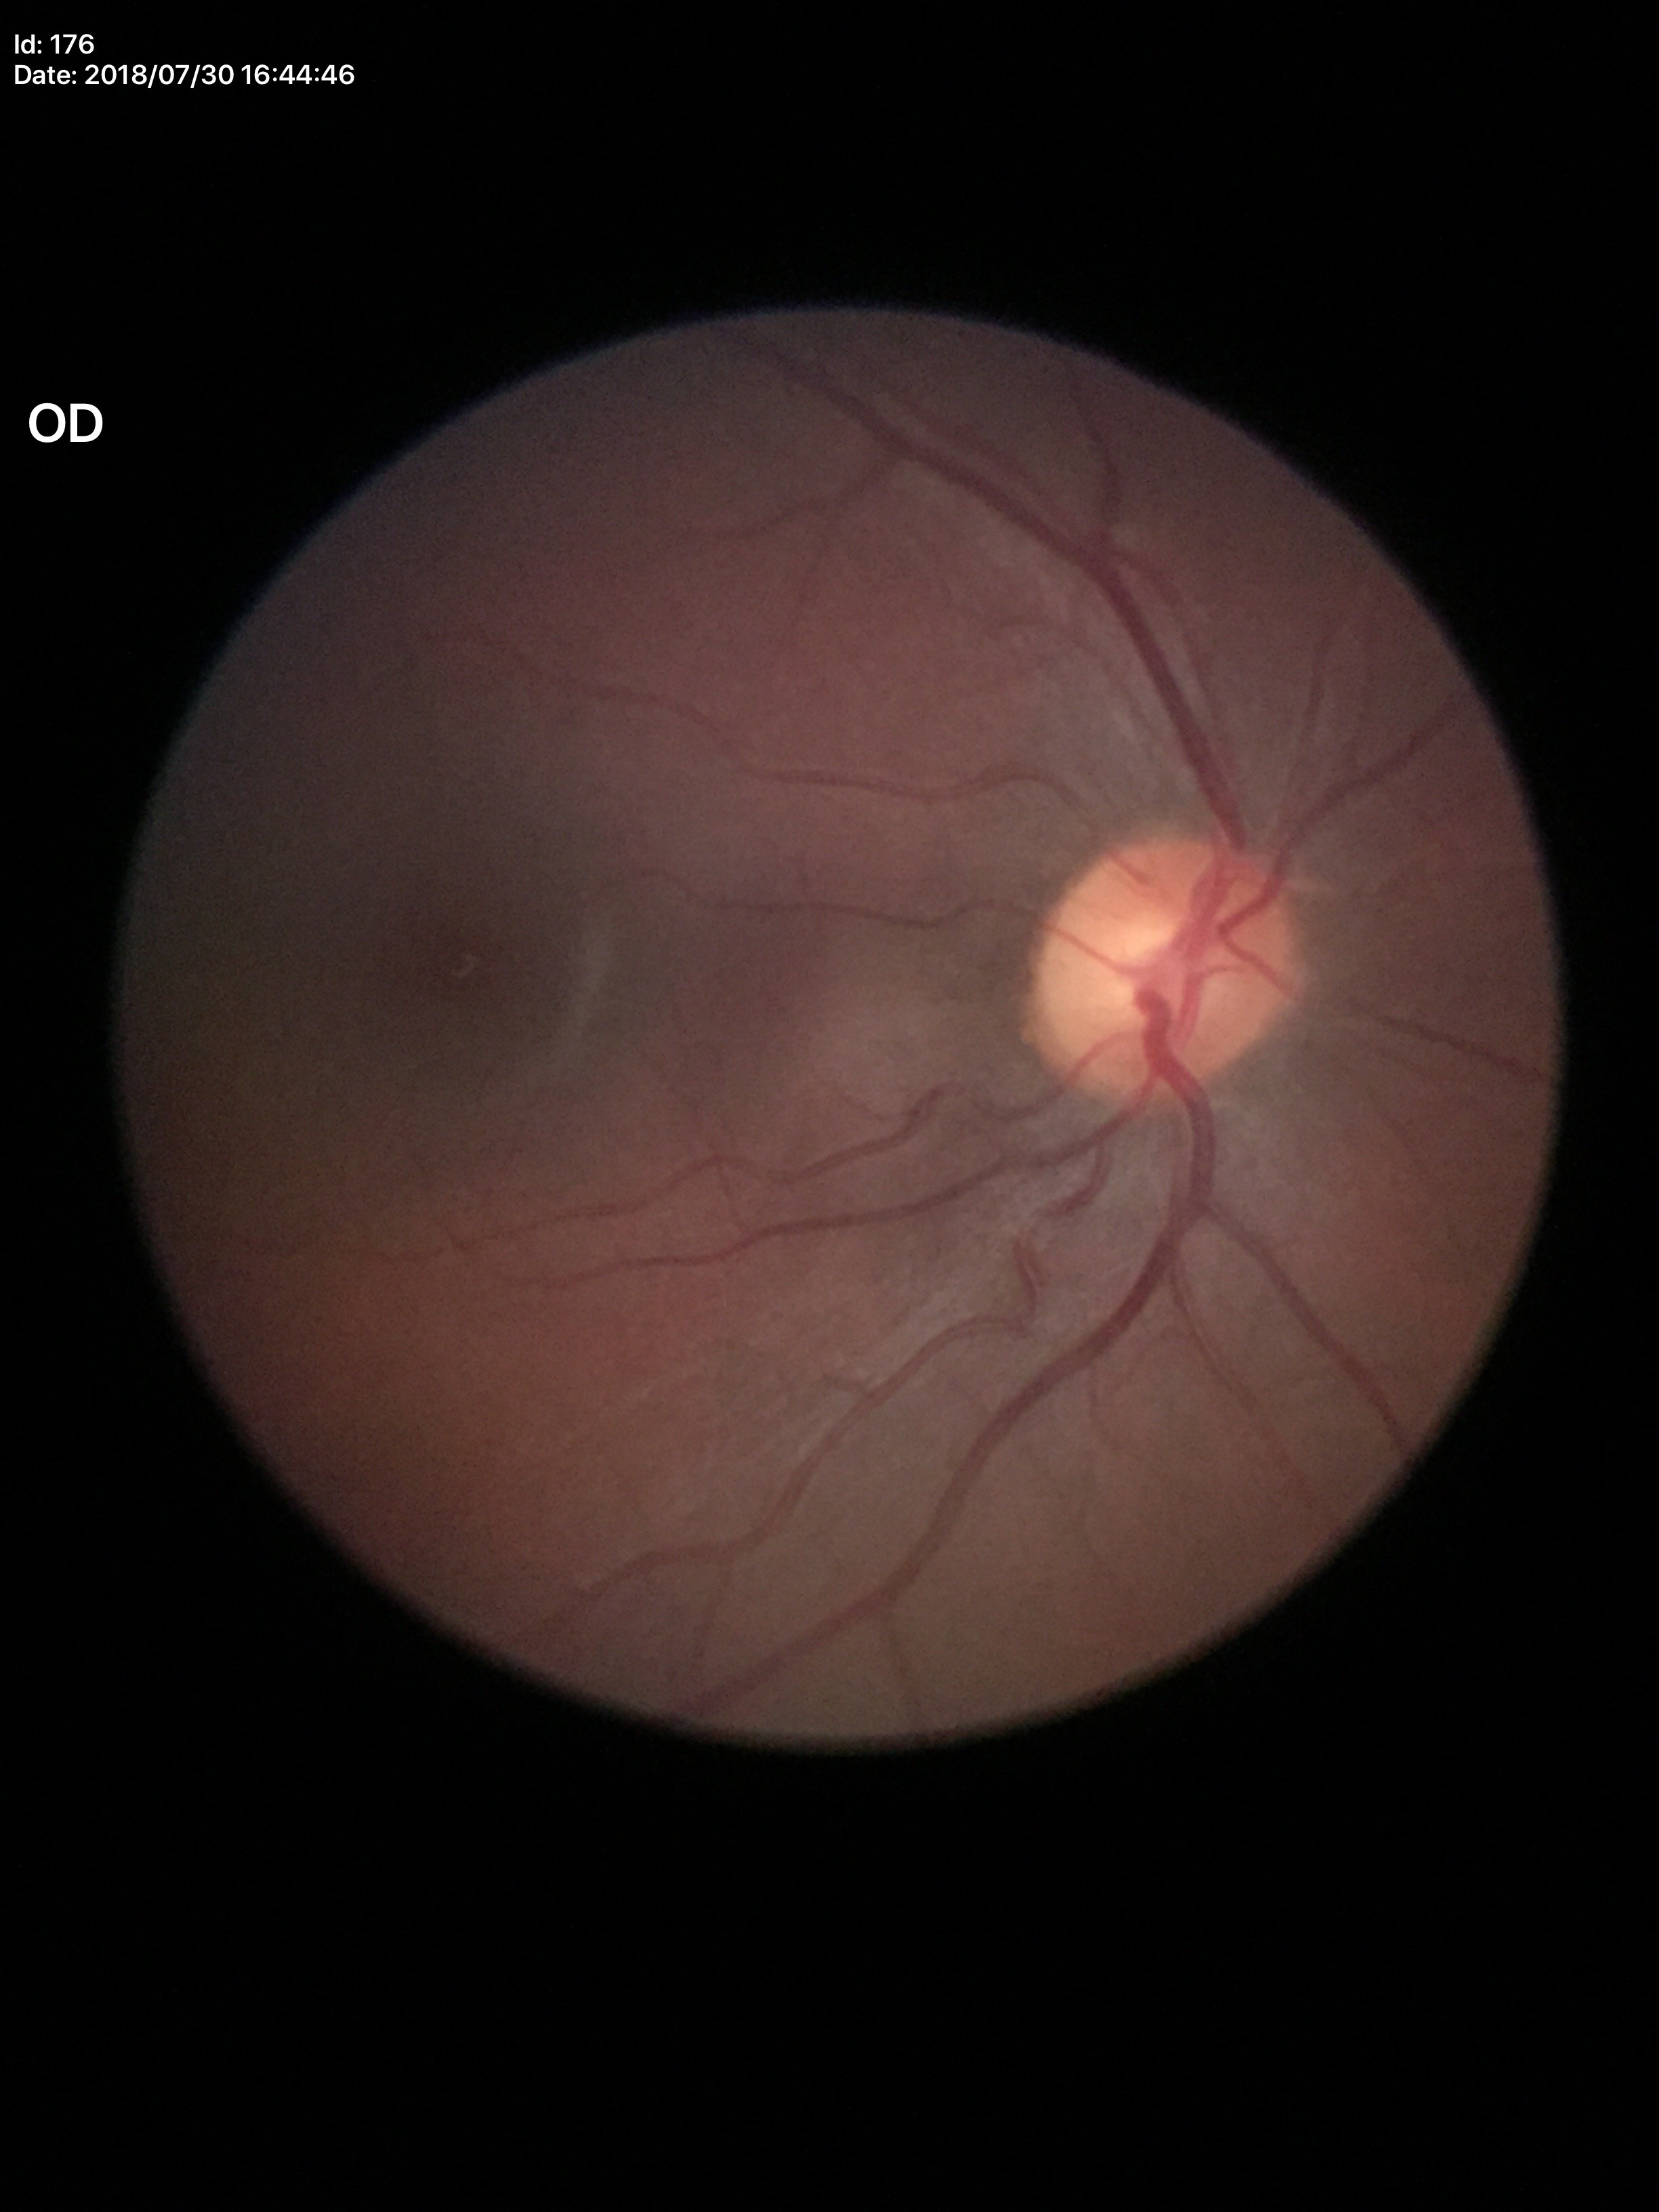

Annotations:
– Glaucoma impression: not suspect
– horizontal cup-to-disc ratio (HCDR): 0.50
– vertical CDR (VCDR): 0.52